848 x 848 pixels, without pupil dilation — 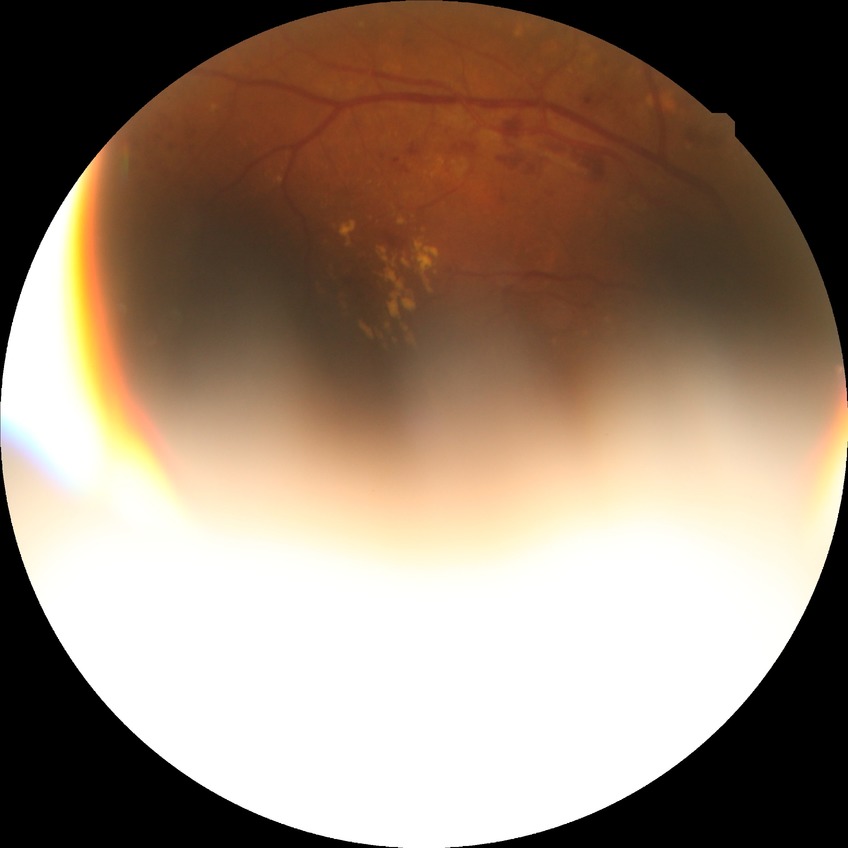

Diabetic retinopathy (DR): pre-proliferative diabetic retinopathy (PPDR).